Wide-field retinal mosaic image.
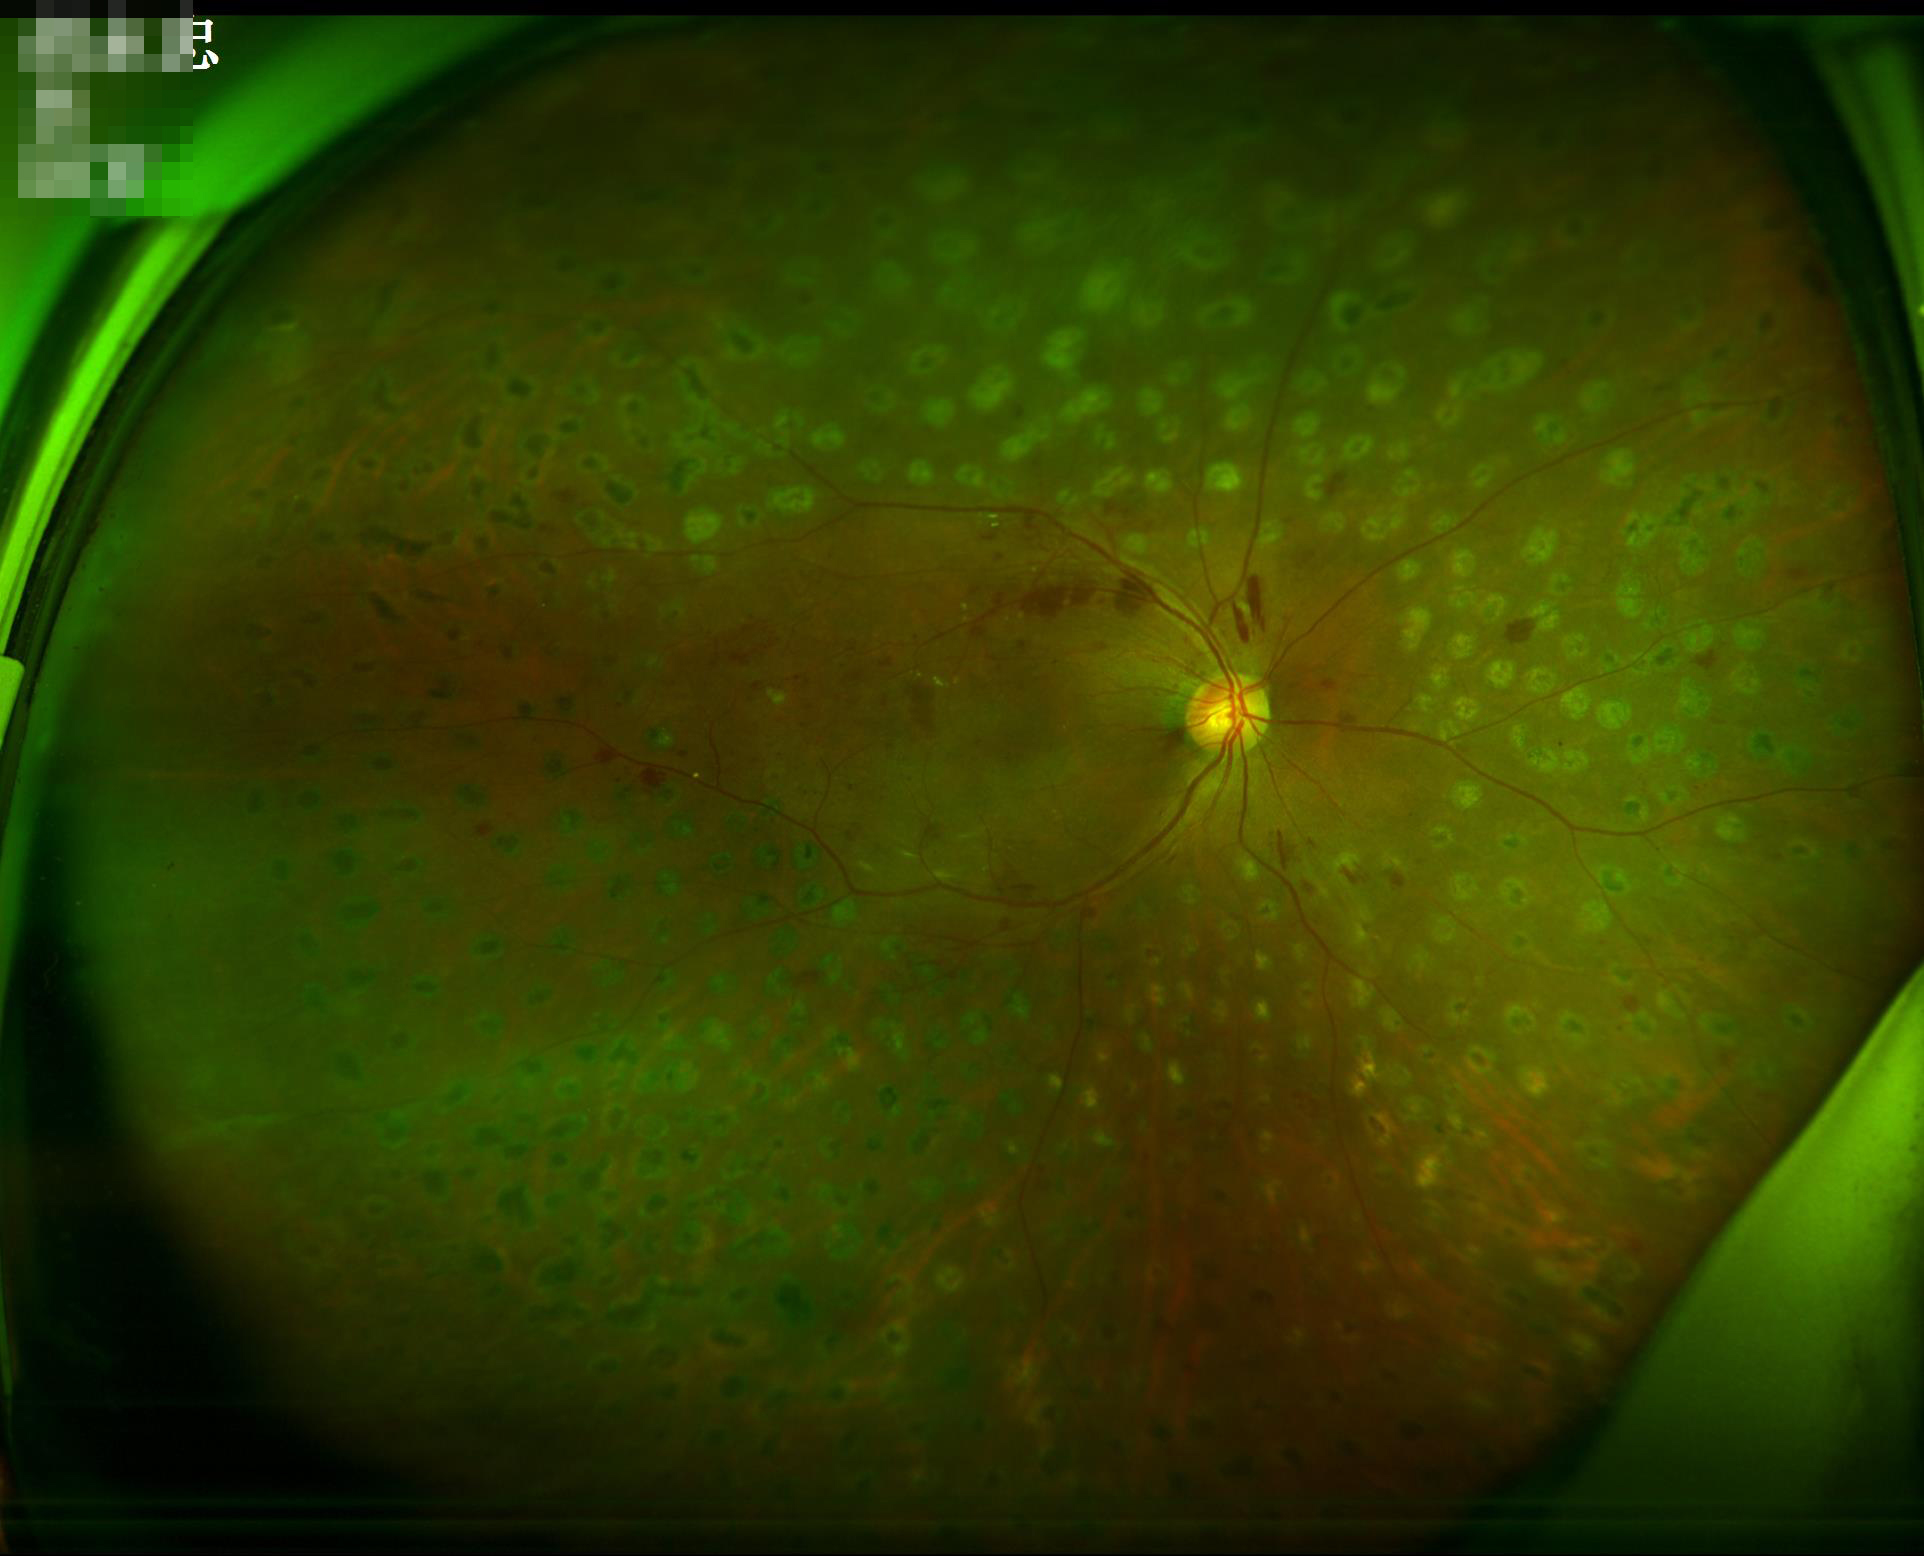 Even illumination with no color cast. Overall quality is good and the image is gradable. Adequate contrast for distinguishing structures. The image is clear.